Corneal thickness 527 µm. Captured without pupil dilation. Sex: female. Fundus photo. Refractive error: -0.75 -4 x 97: 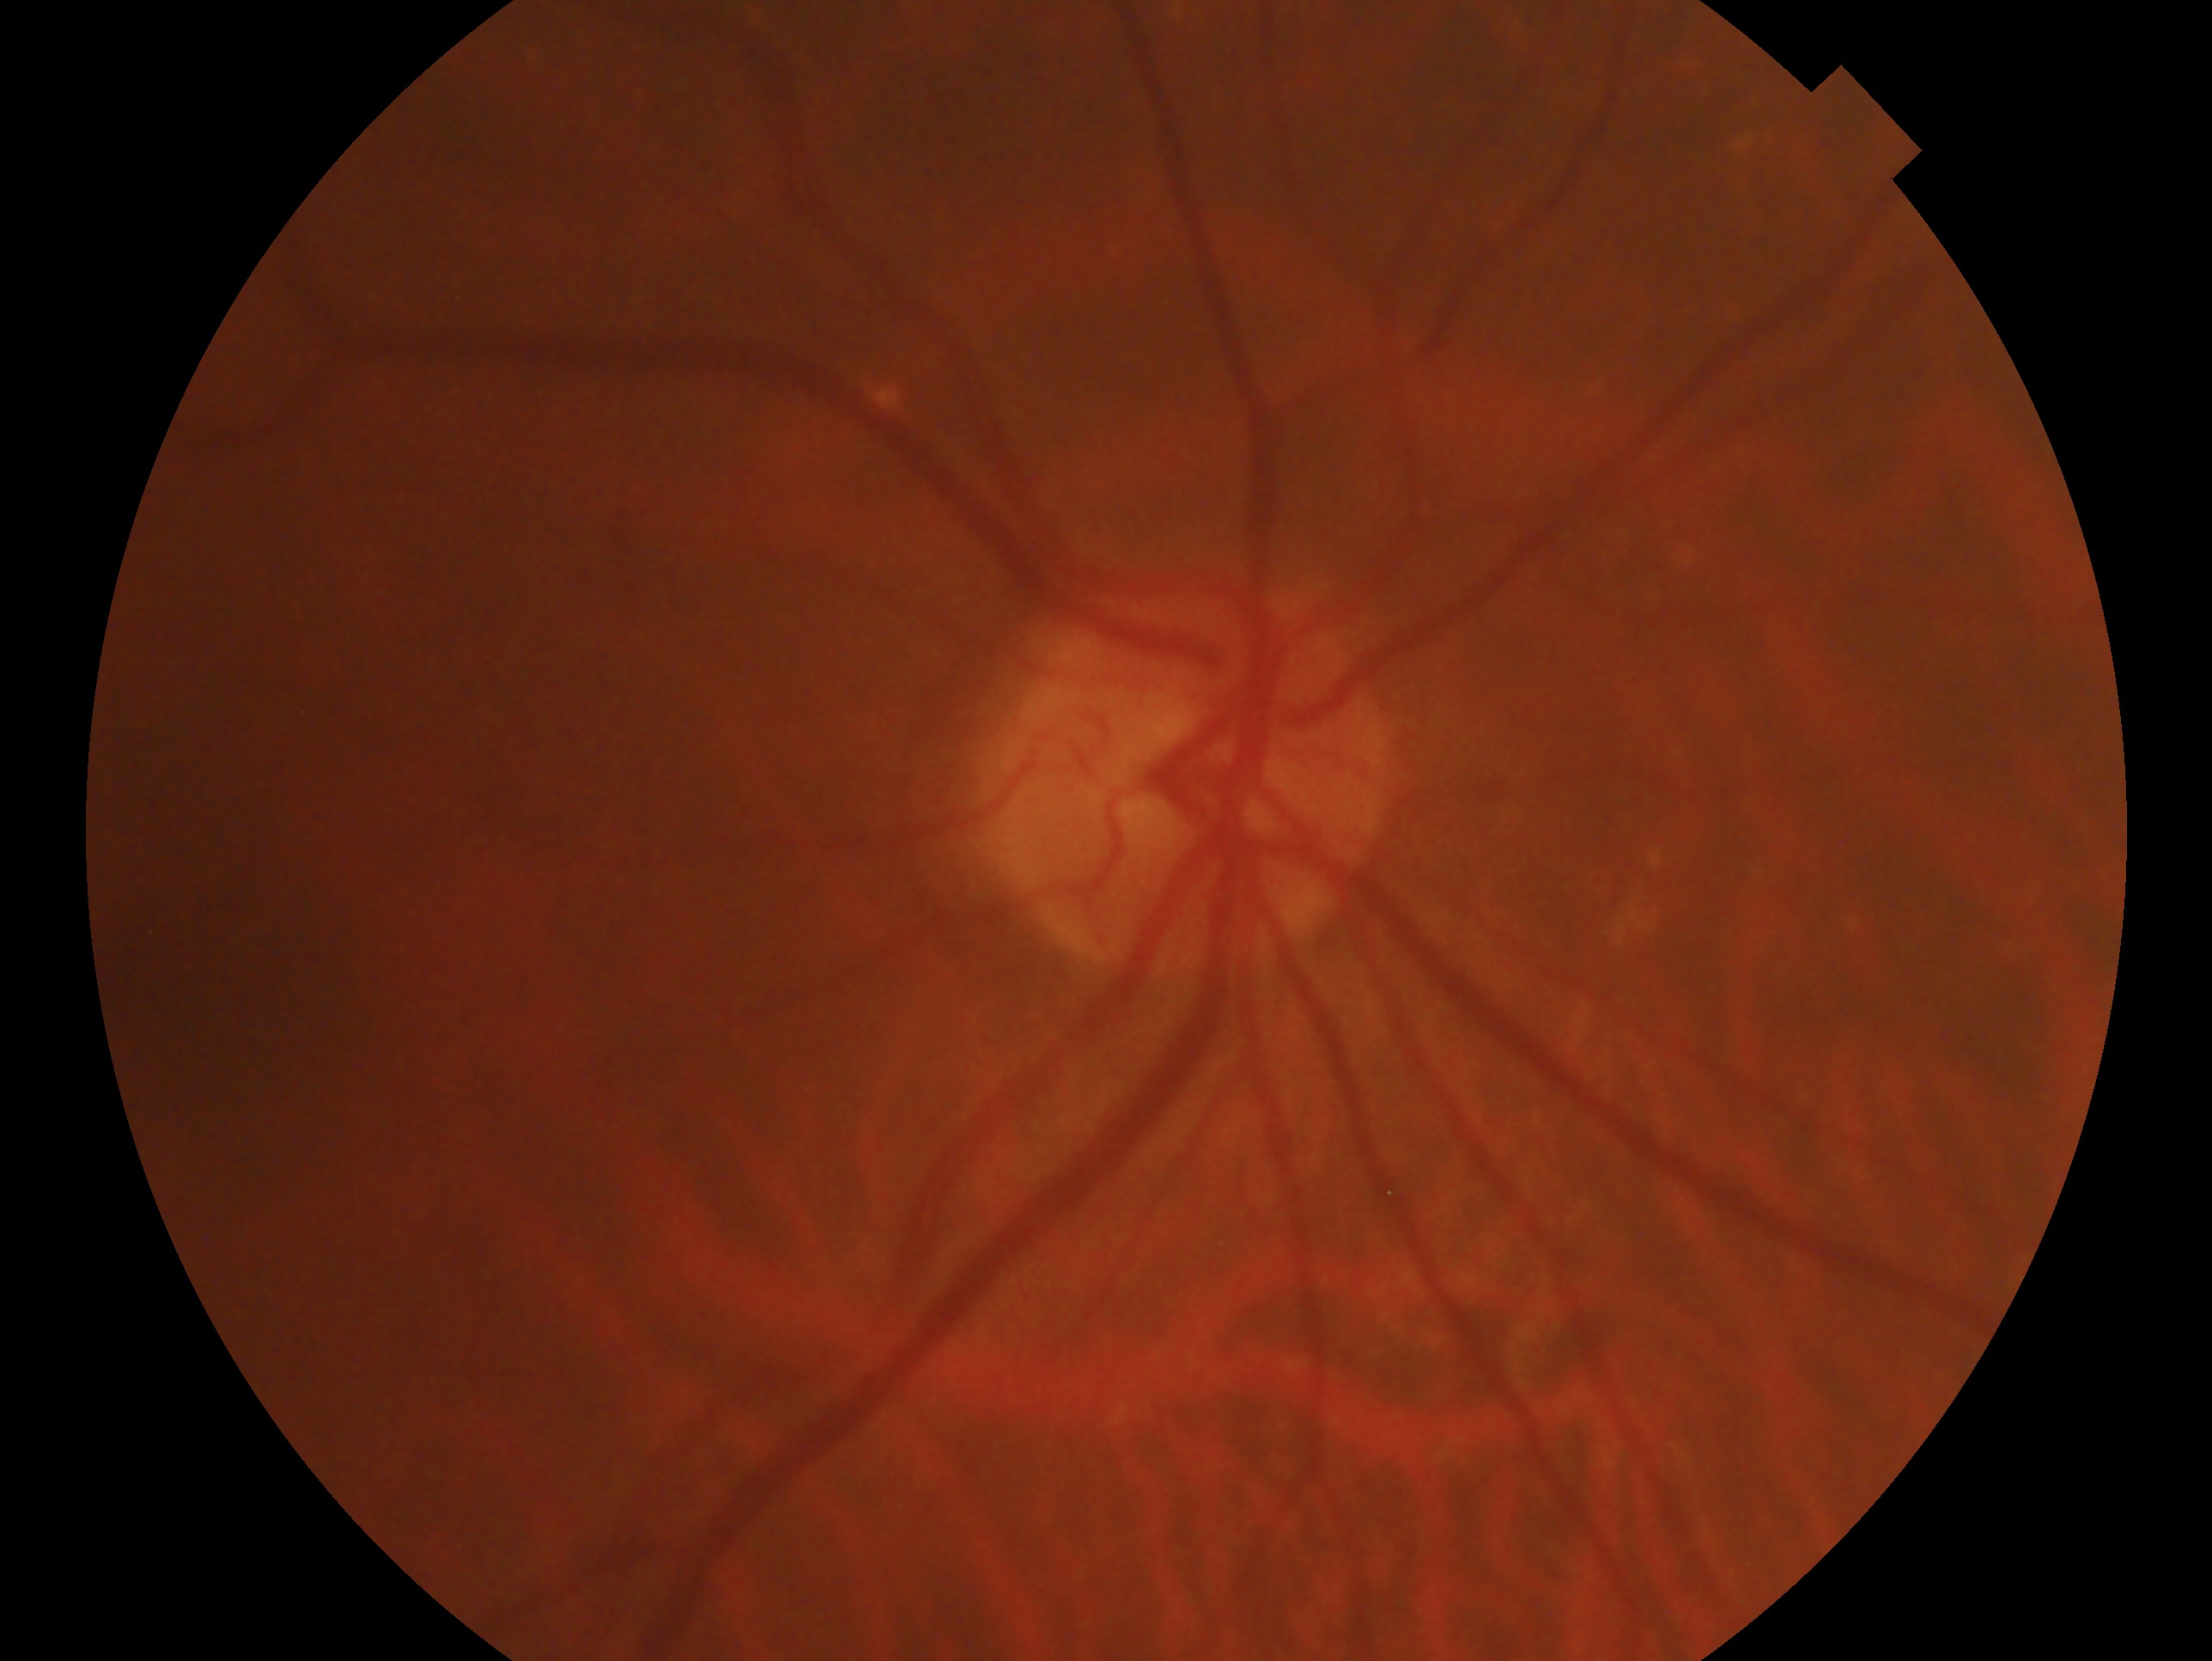

This is the oculus dexter. Glaucoma status — negative for glaucoma.